45 degree fundus photograph, no pharmacologic dilation, NIDEK AFC-230 fundus camera
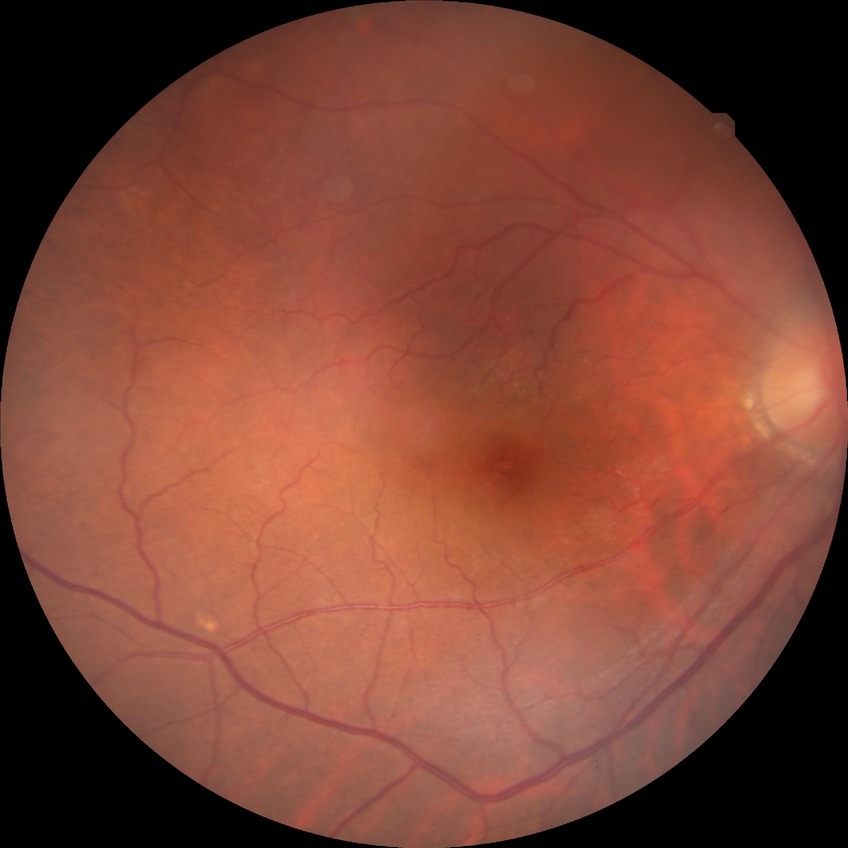

DR grade: NDR. No apparent diabetic retinopathy.